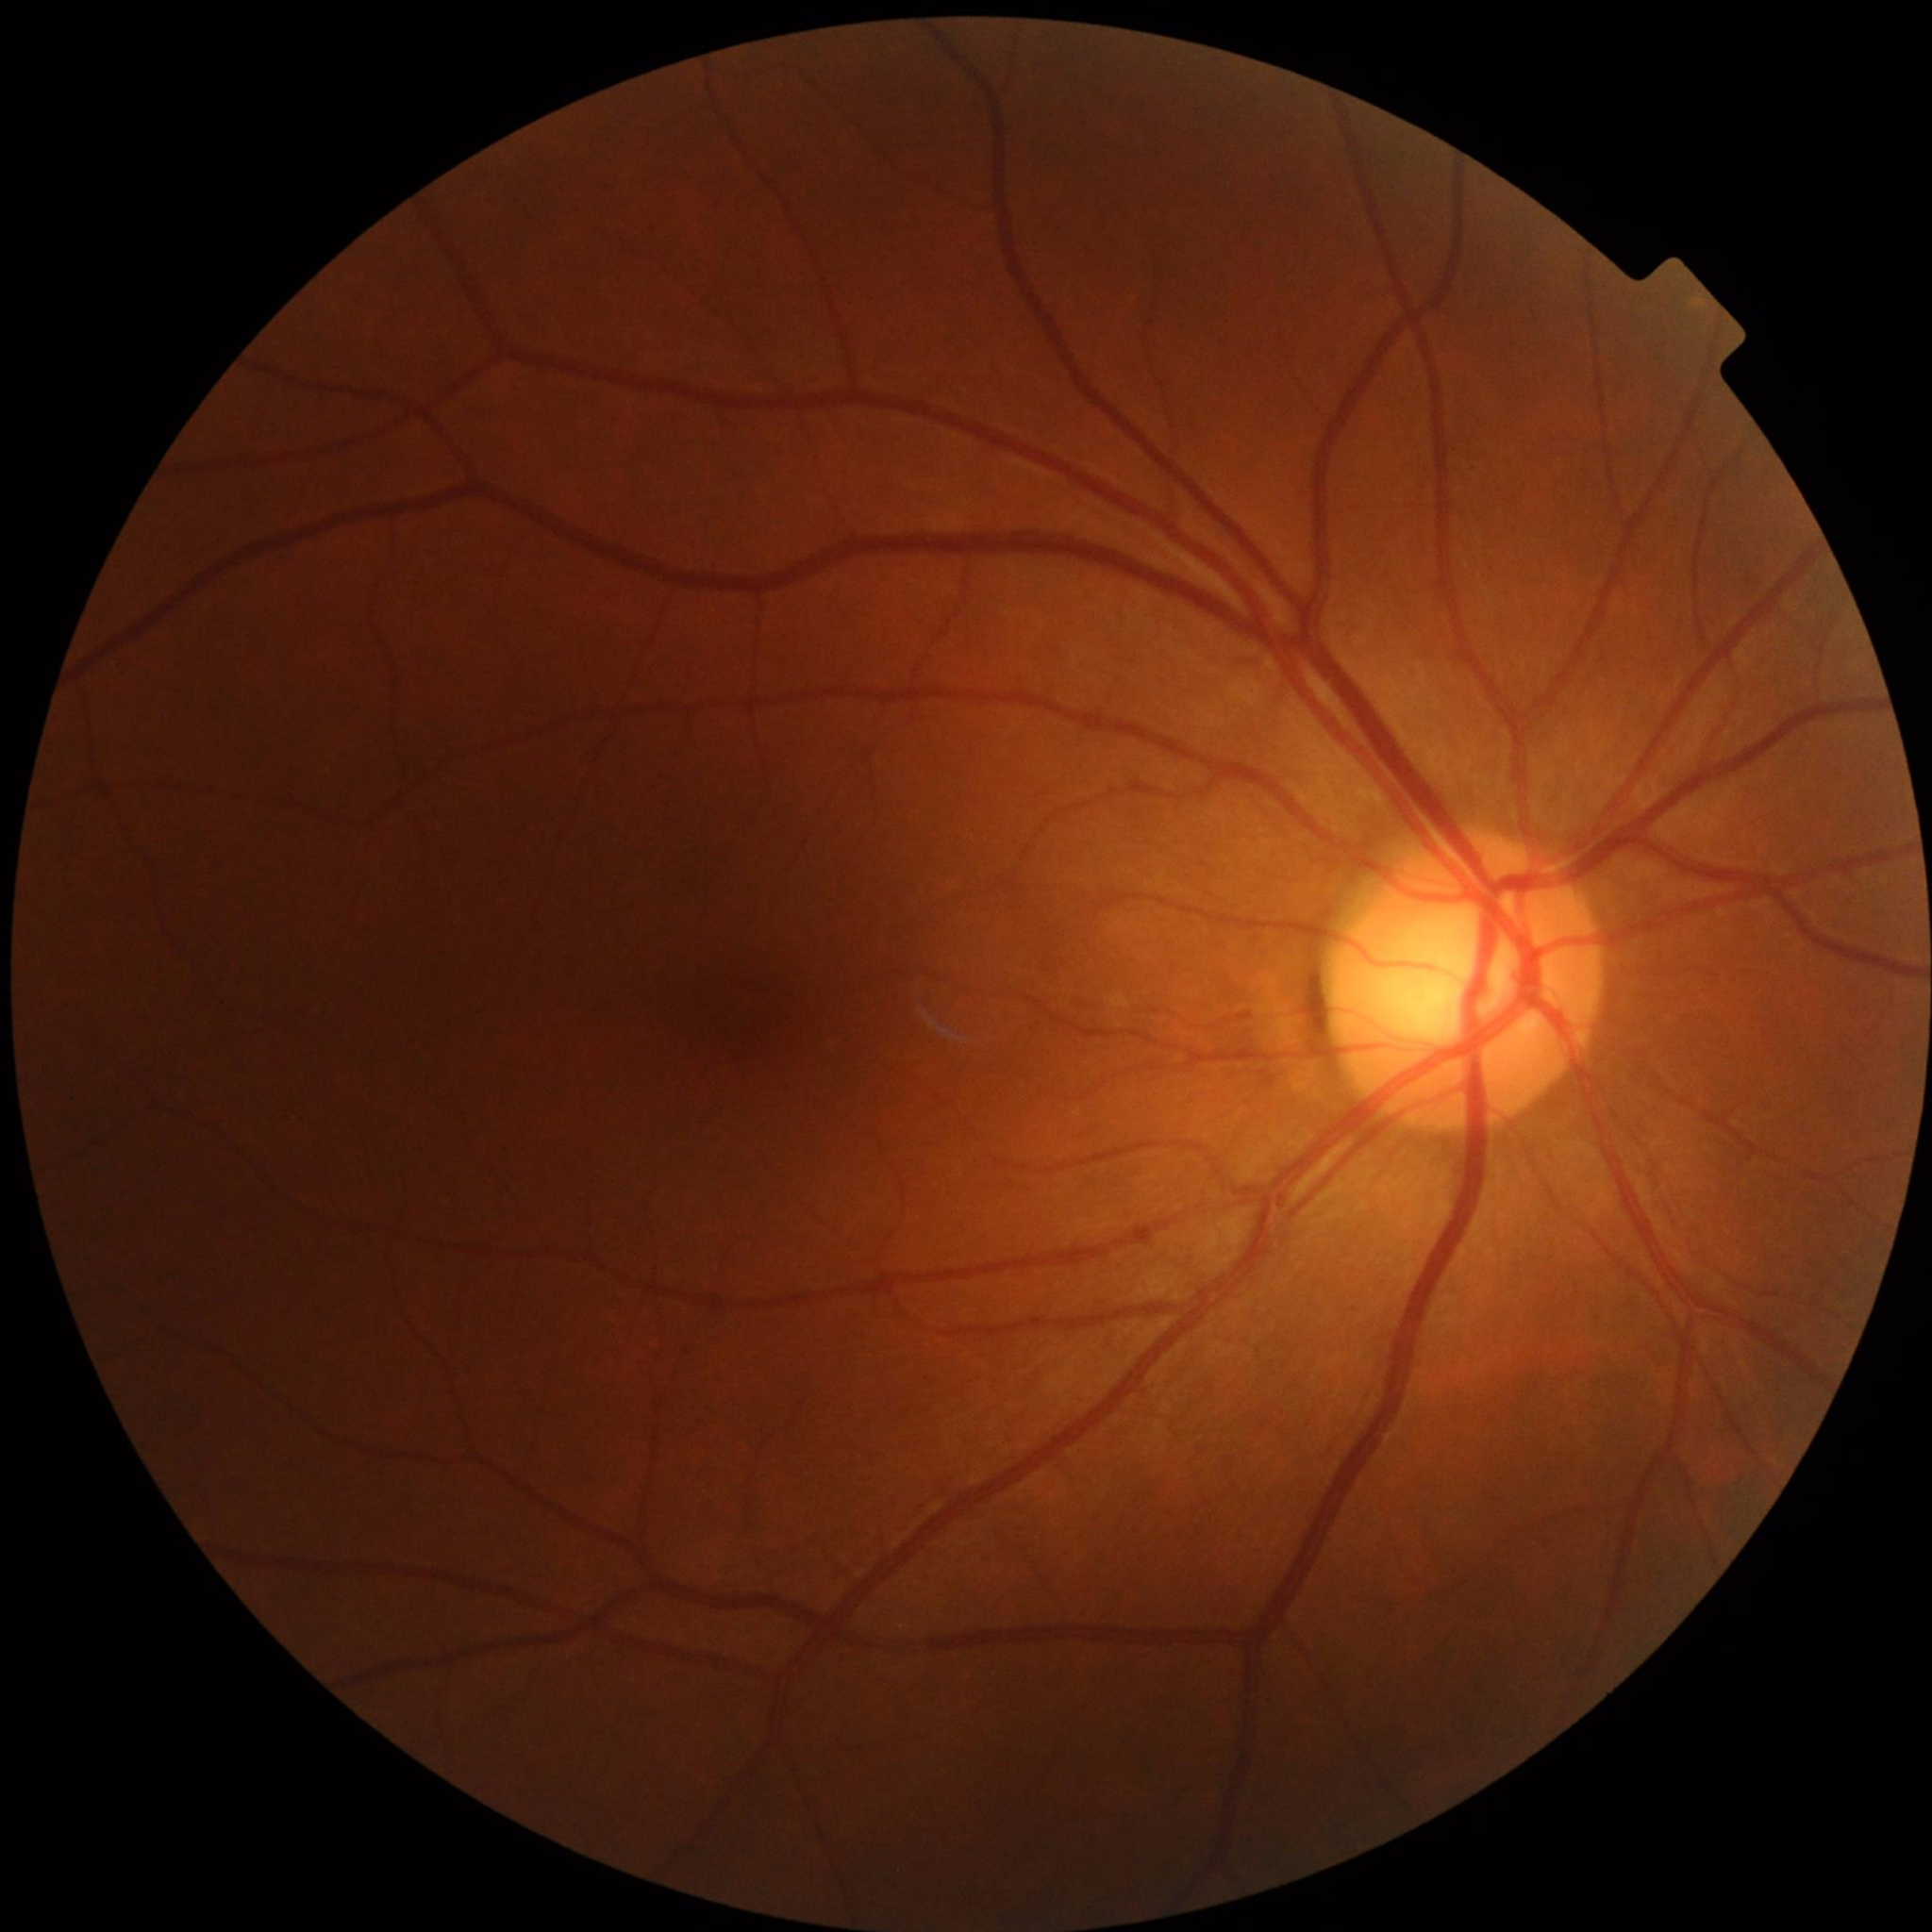

Clinical diagnosis: no AMD, DR, or glaucomatous findings.